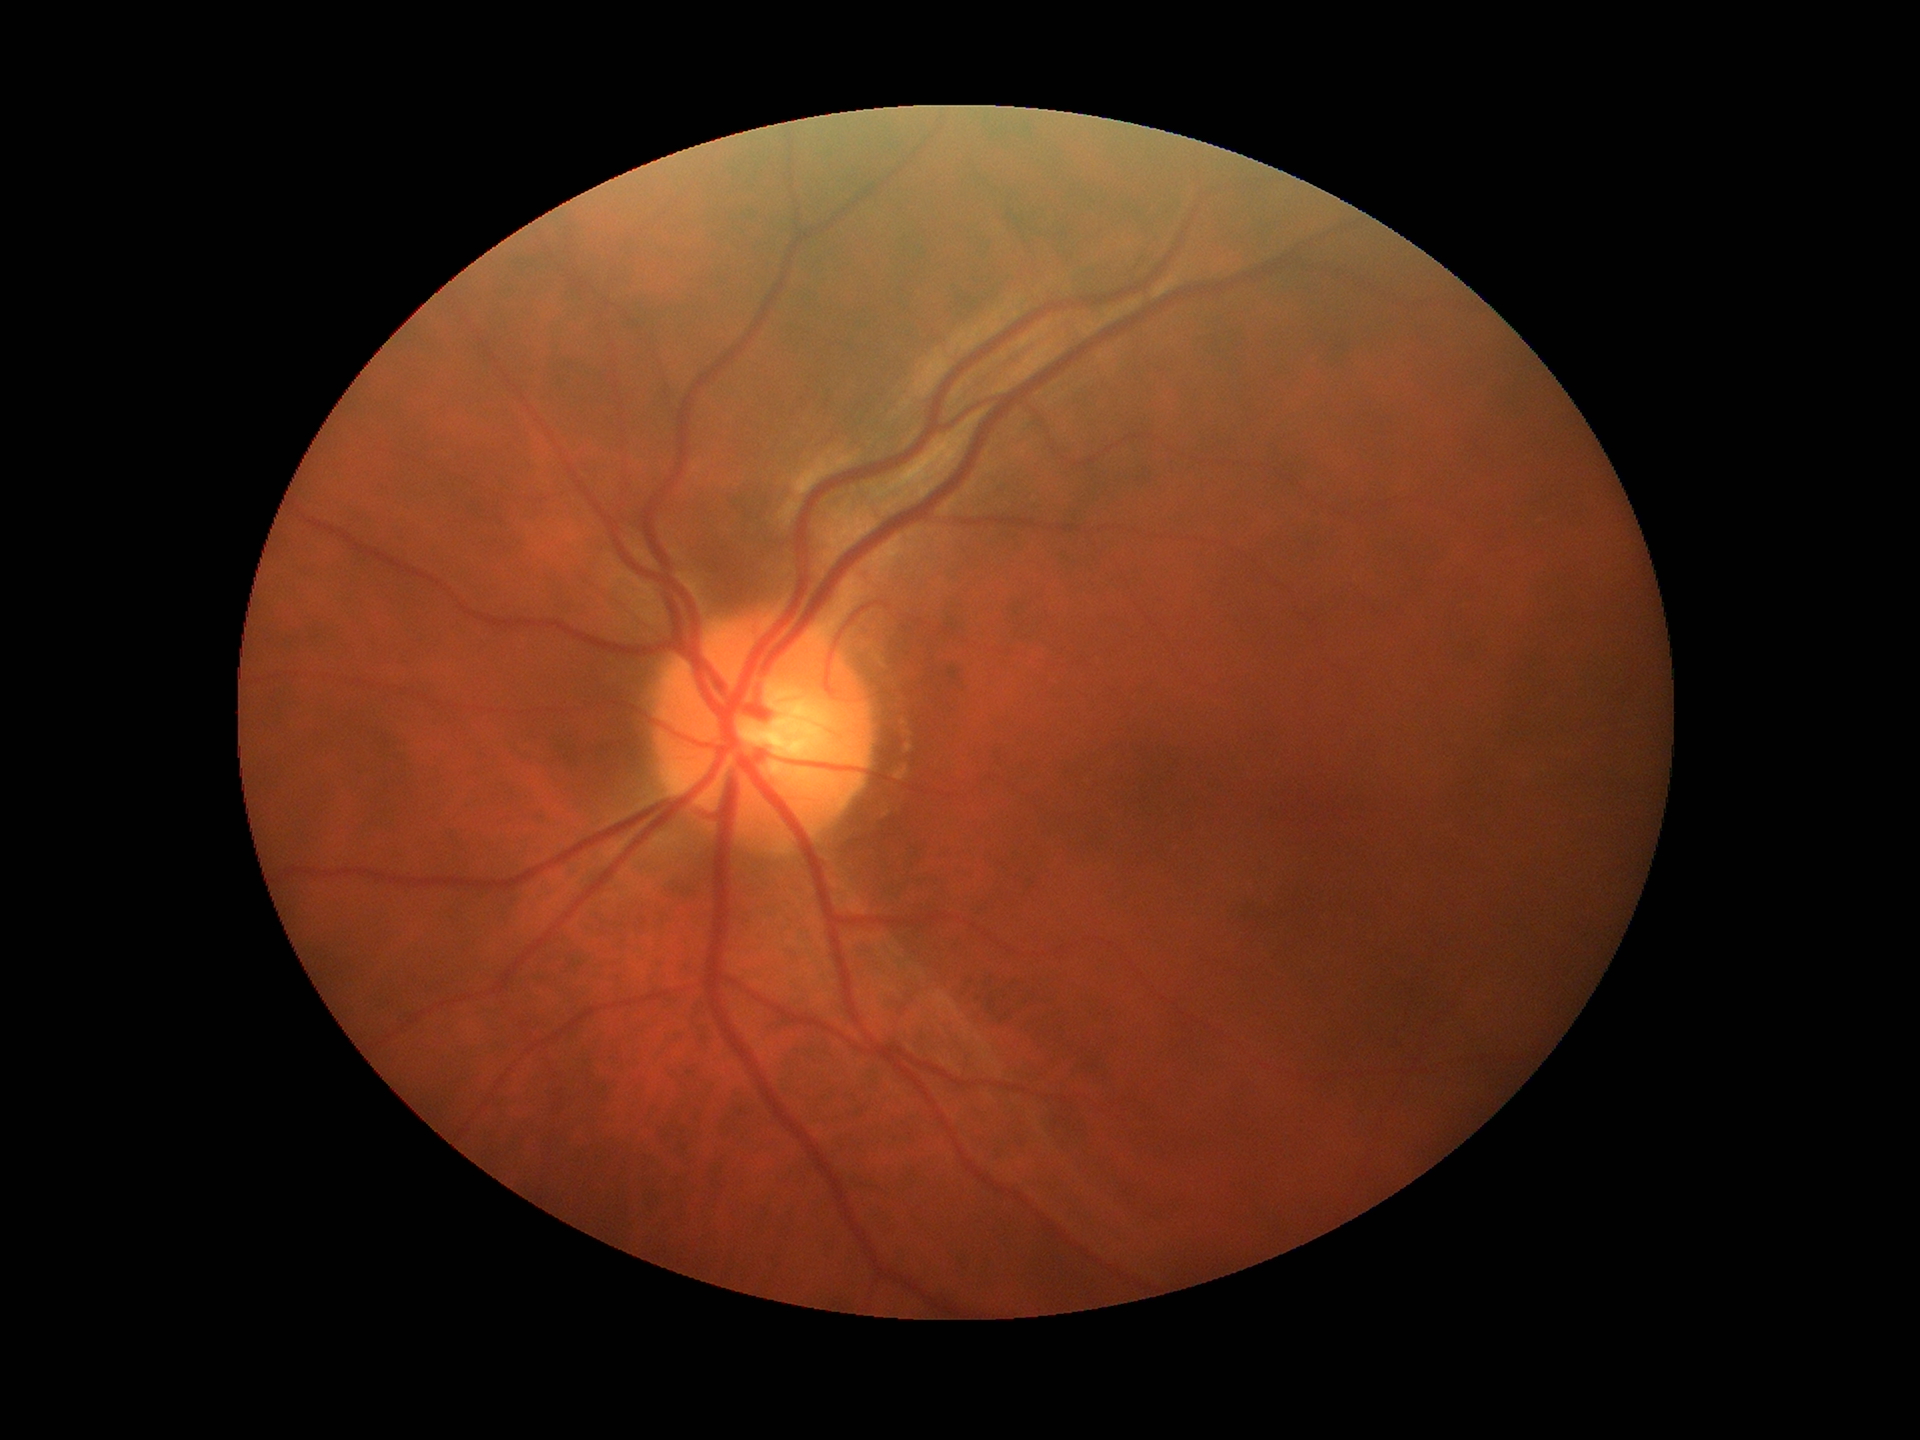 Area CDR of 0.26. Horizontal cup-to-disc ratio of 0.53. Vertical C/D ratio: 0.50. Glaucoma assessment: negative.